2048x1536 — 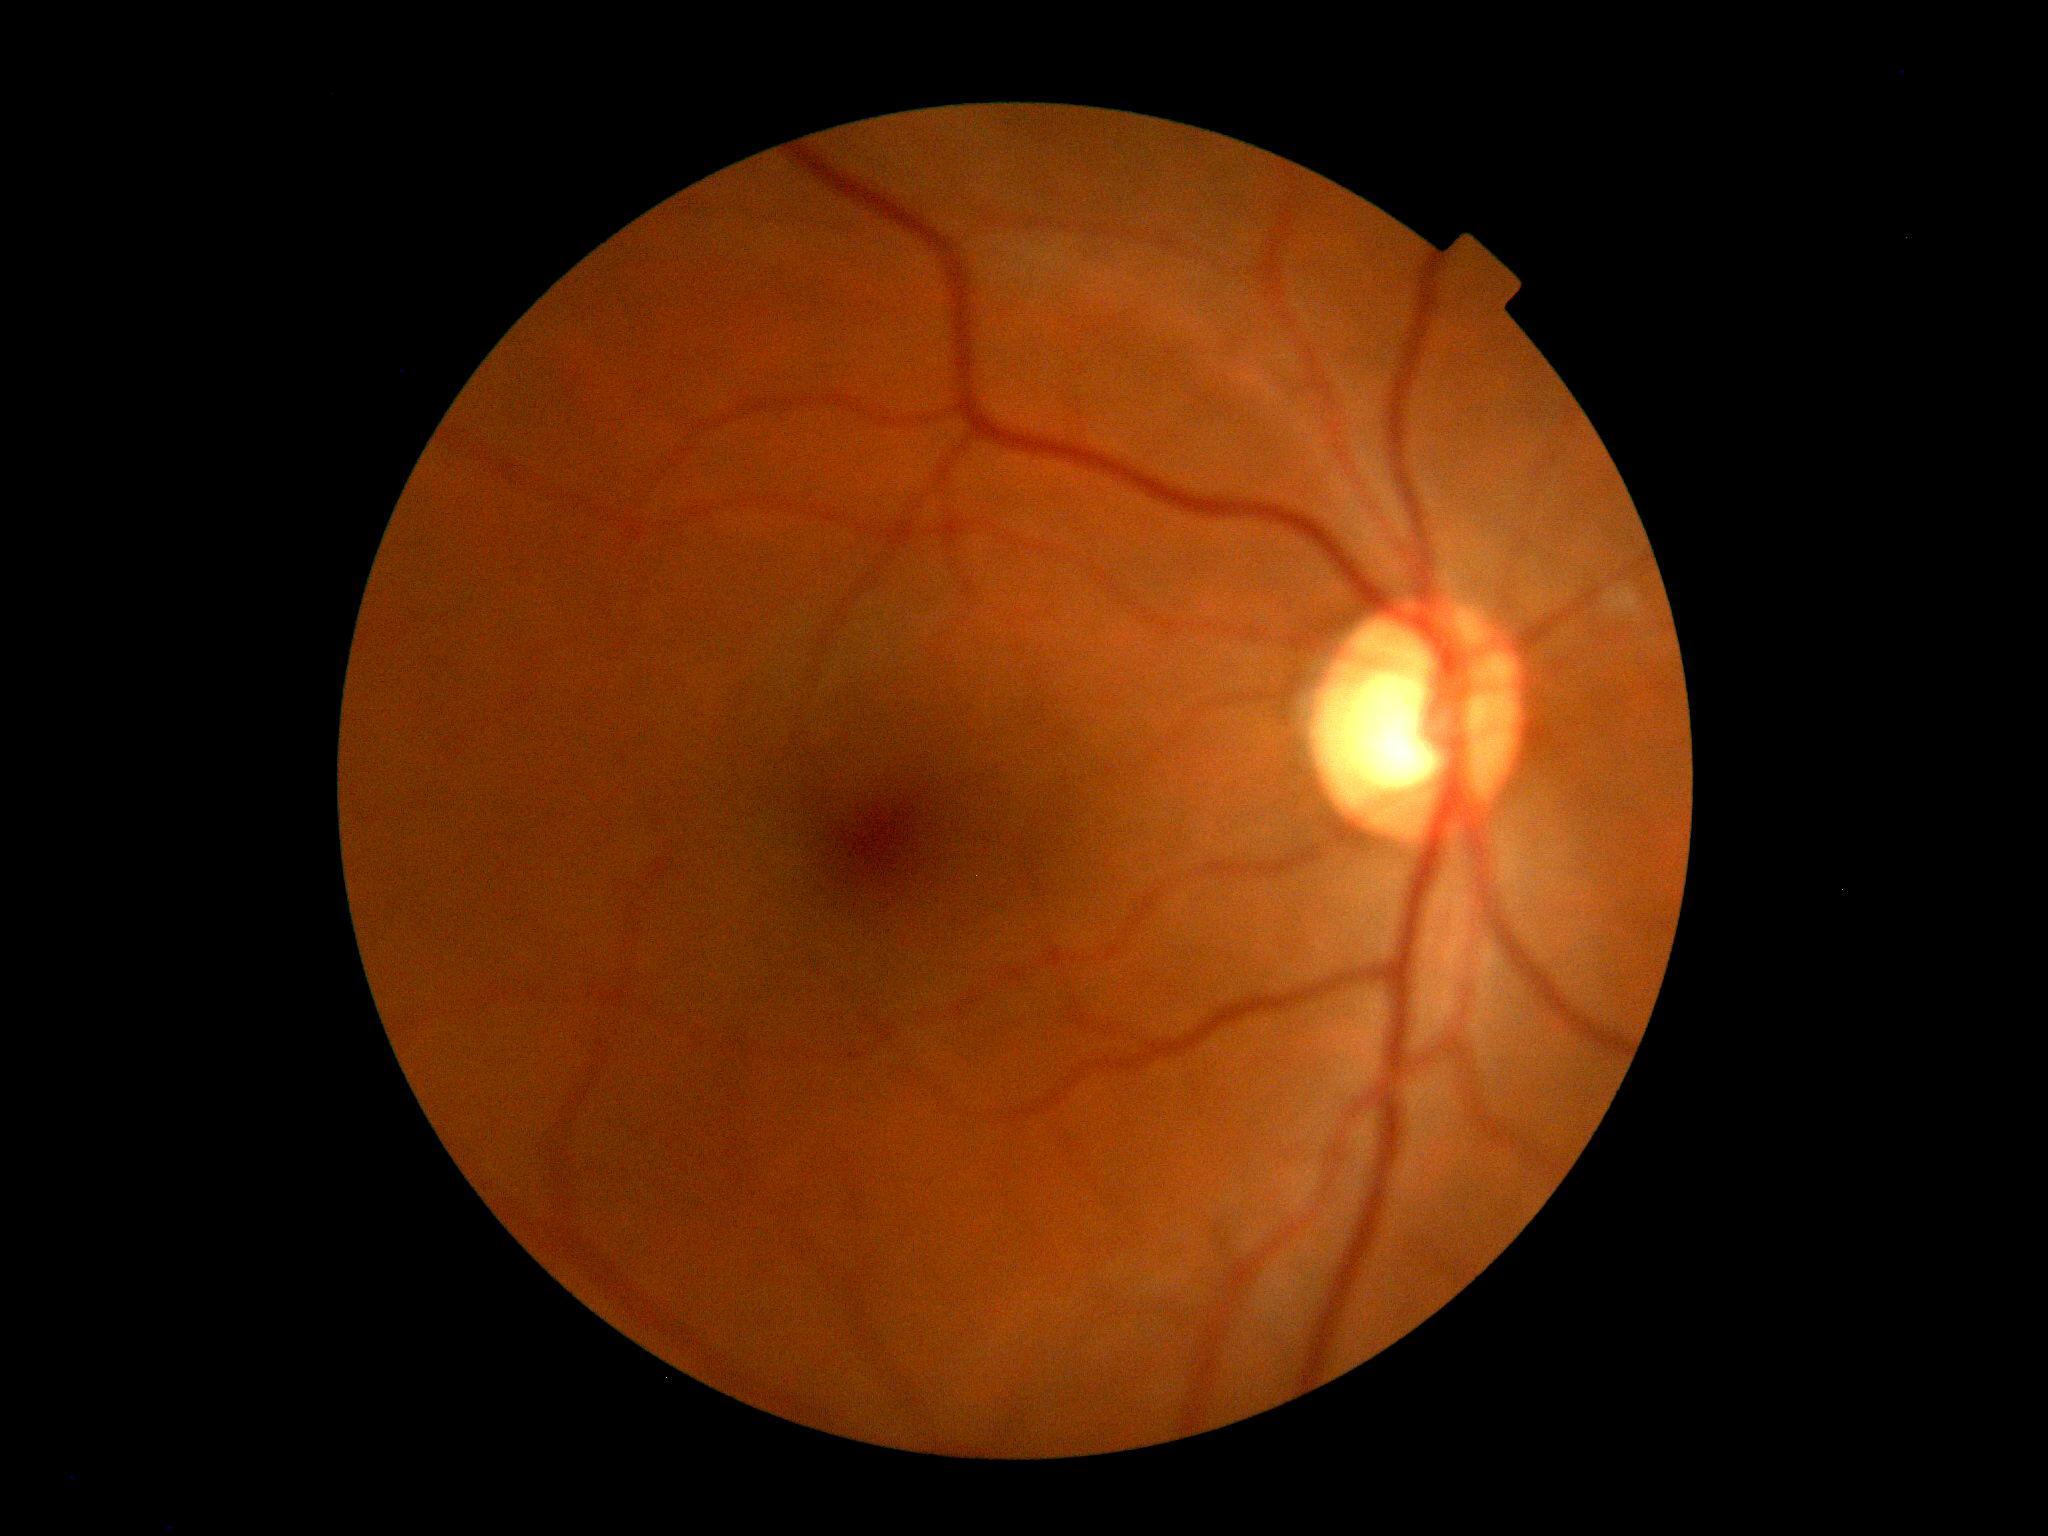
No signs of diabetic retinopathy.
Retinopathy grade: 0.